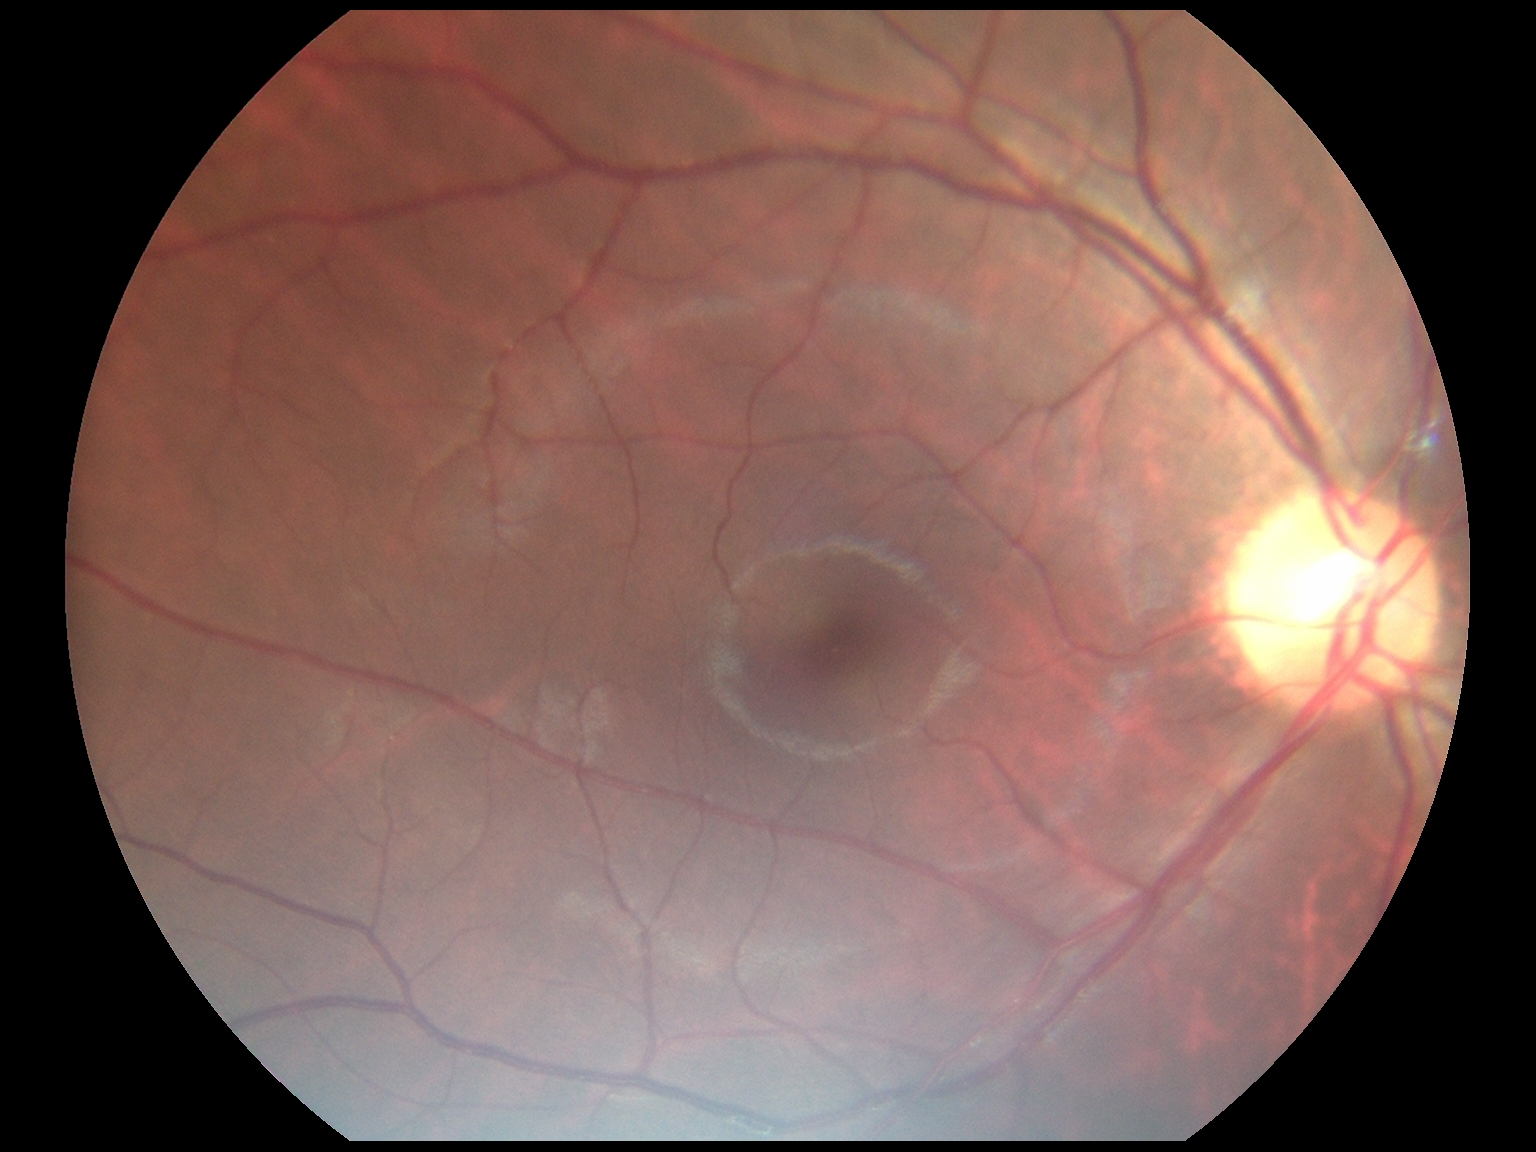

No DR findings.
Retinopathy: 0/4.